Acquired on the Natus RetCam Envision; wide-field fundus photograph from neonatal ROP screening: 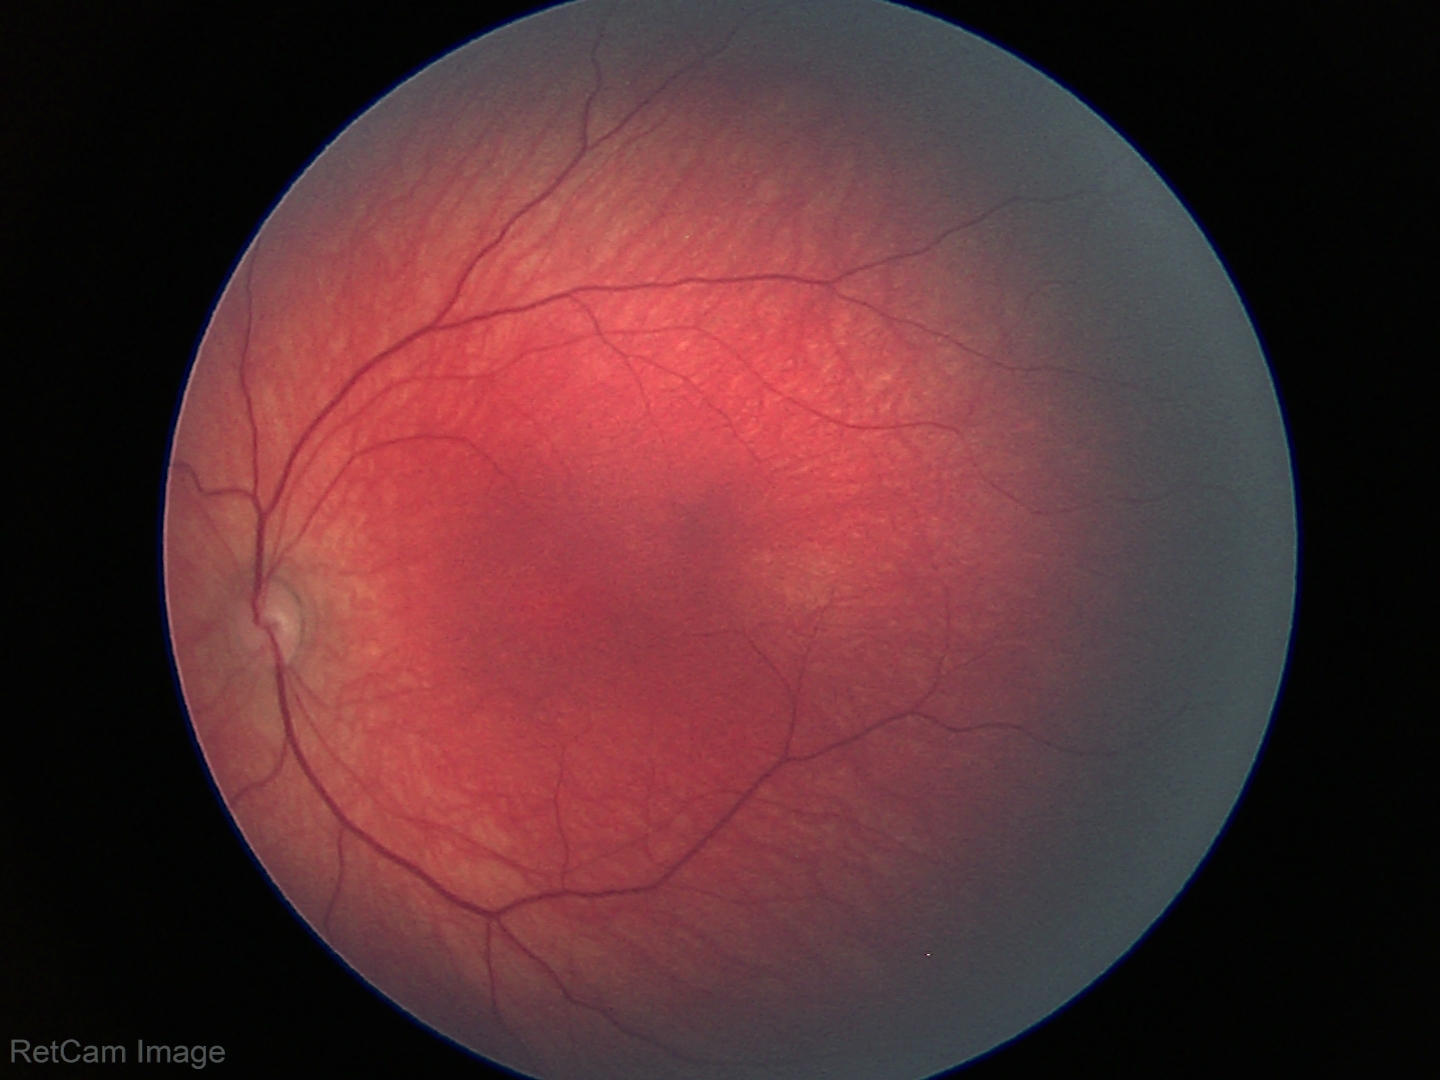
Screening examination with no abnormal retinal findings.